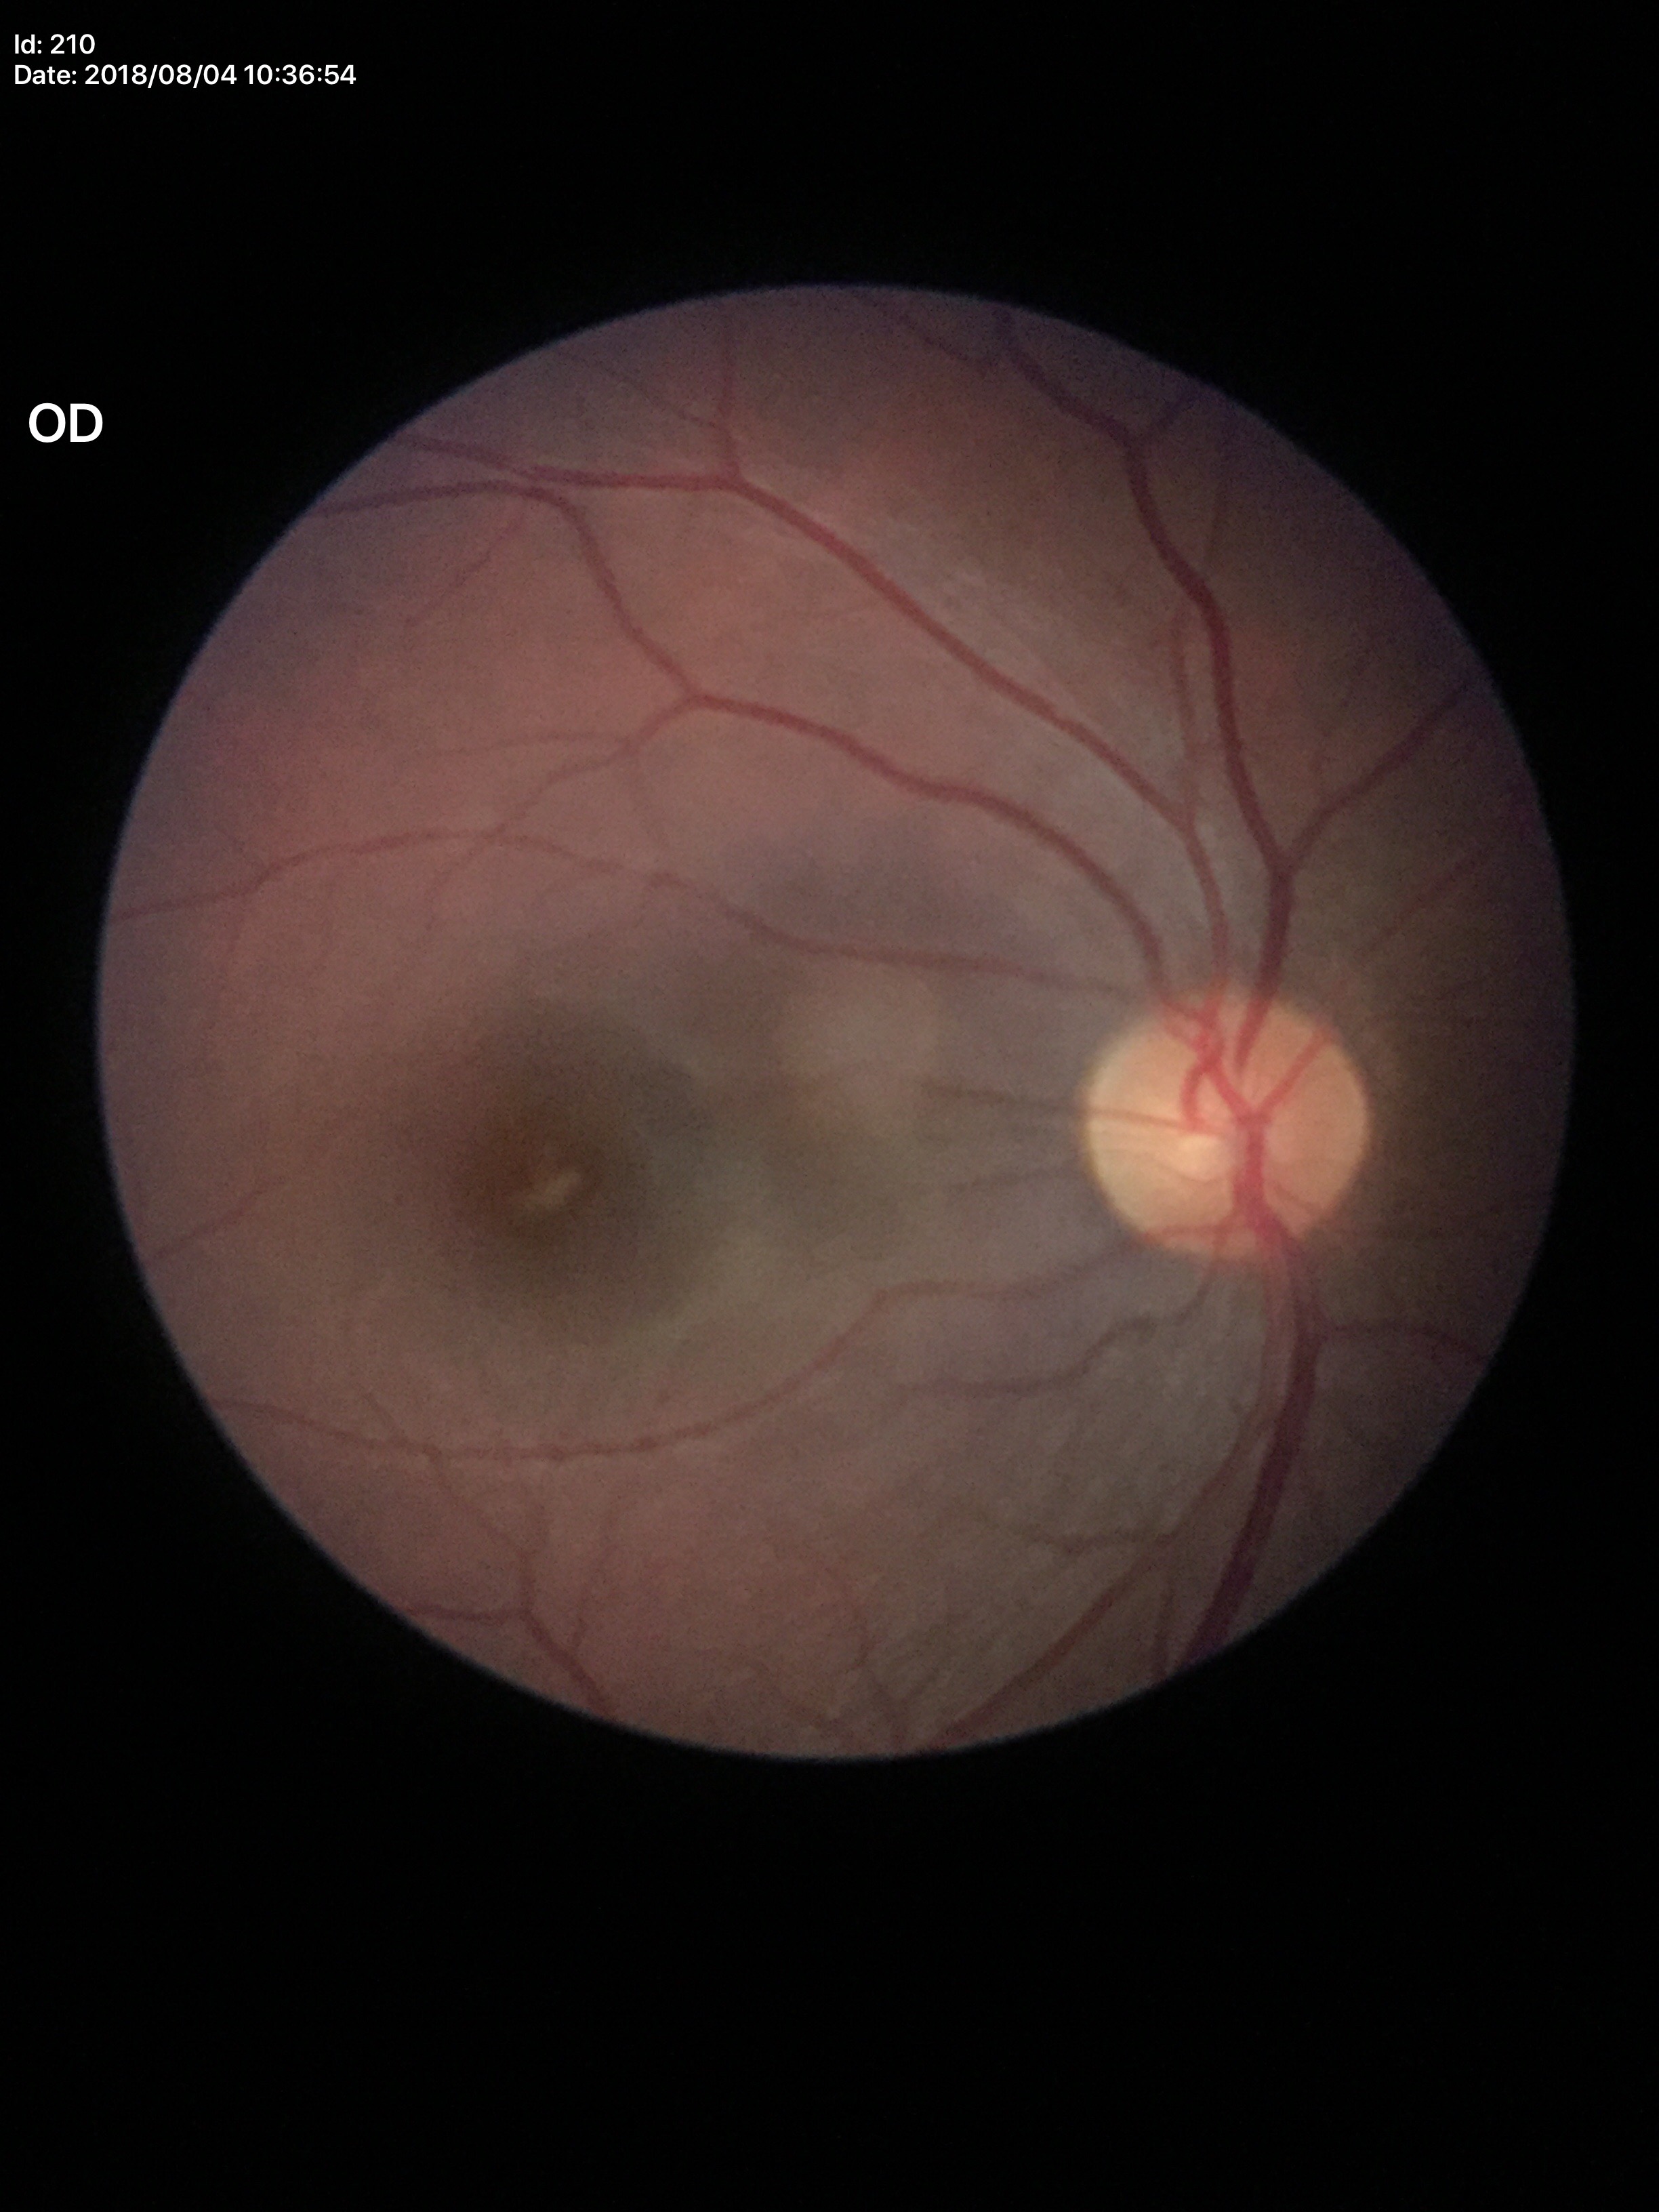

No evidence of glaucoma. Vertical cup-to-disc ratio (VCDR): 0.45.